Wide-field fundus photograph of an infant · camera: Phoenix ICON (100° FOV) · image size 1240x1240.
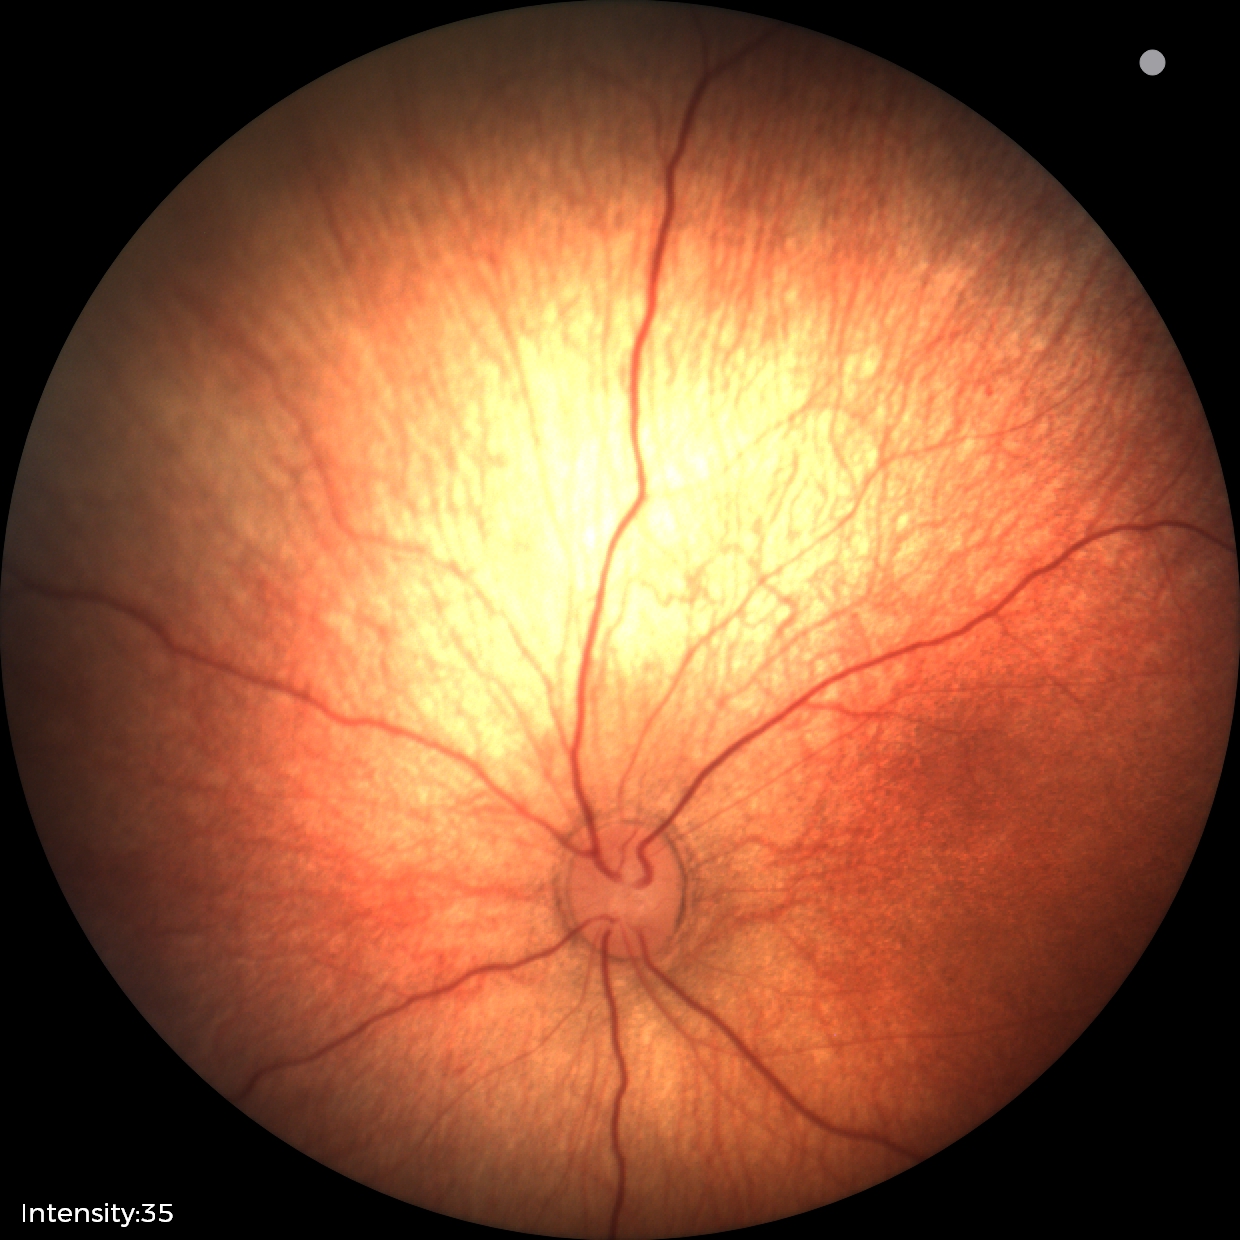
Screening examination diagnosed as physiological.